Without pupil dilation
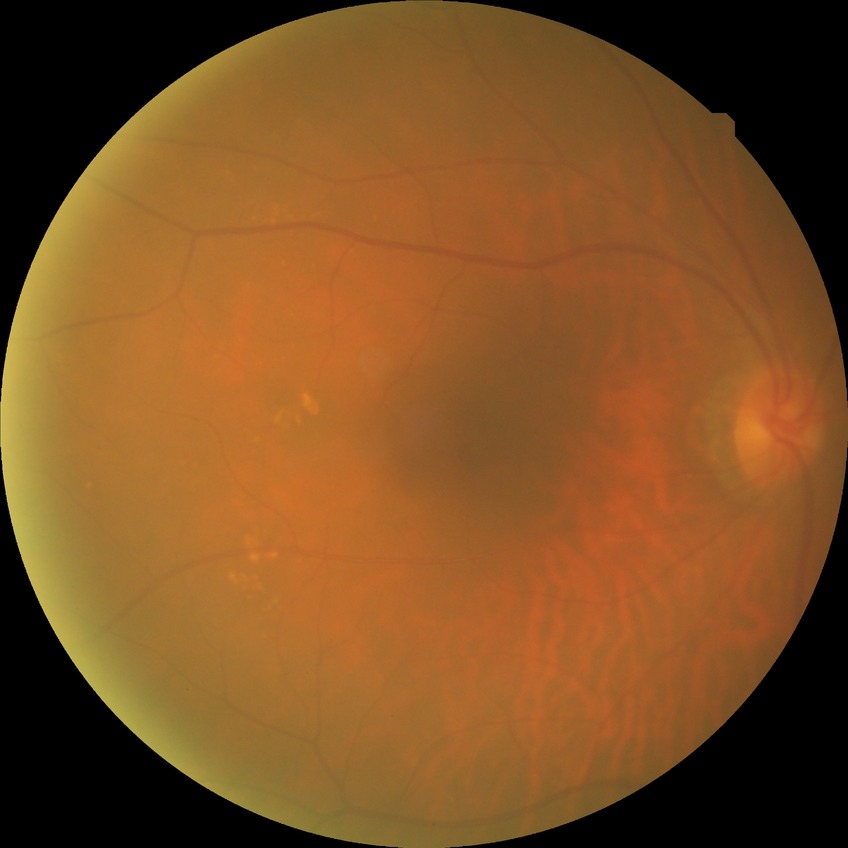

diabetic retinopathy (DR): no diabetic retinopathy (NDR).